Age 42 · axial length: 24.4 mm · intraocular pressure (IOP) 11 mmHg (non-contact tonometry) · man · autorefraction: sphere -3 D, cylinder -1.75 D, axis 110° · 30° FOV · corneal thickness 526 µm: 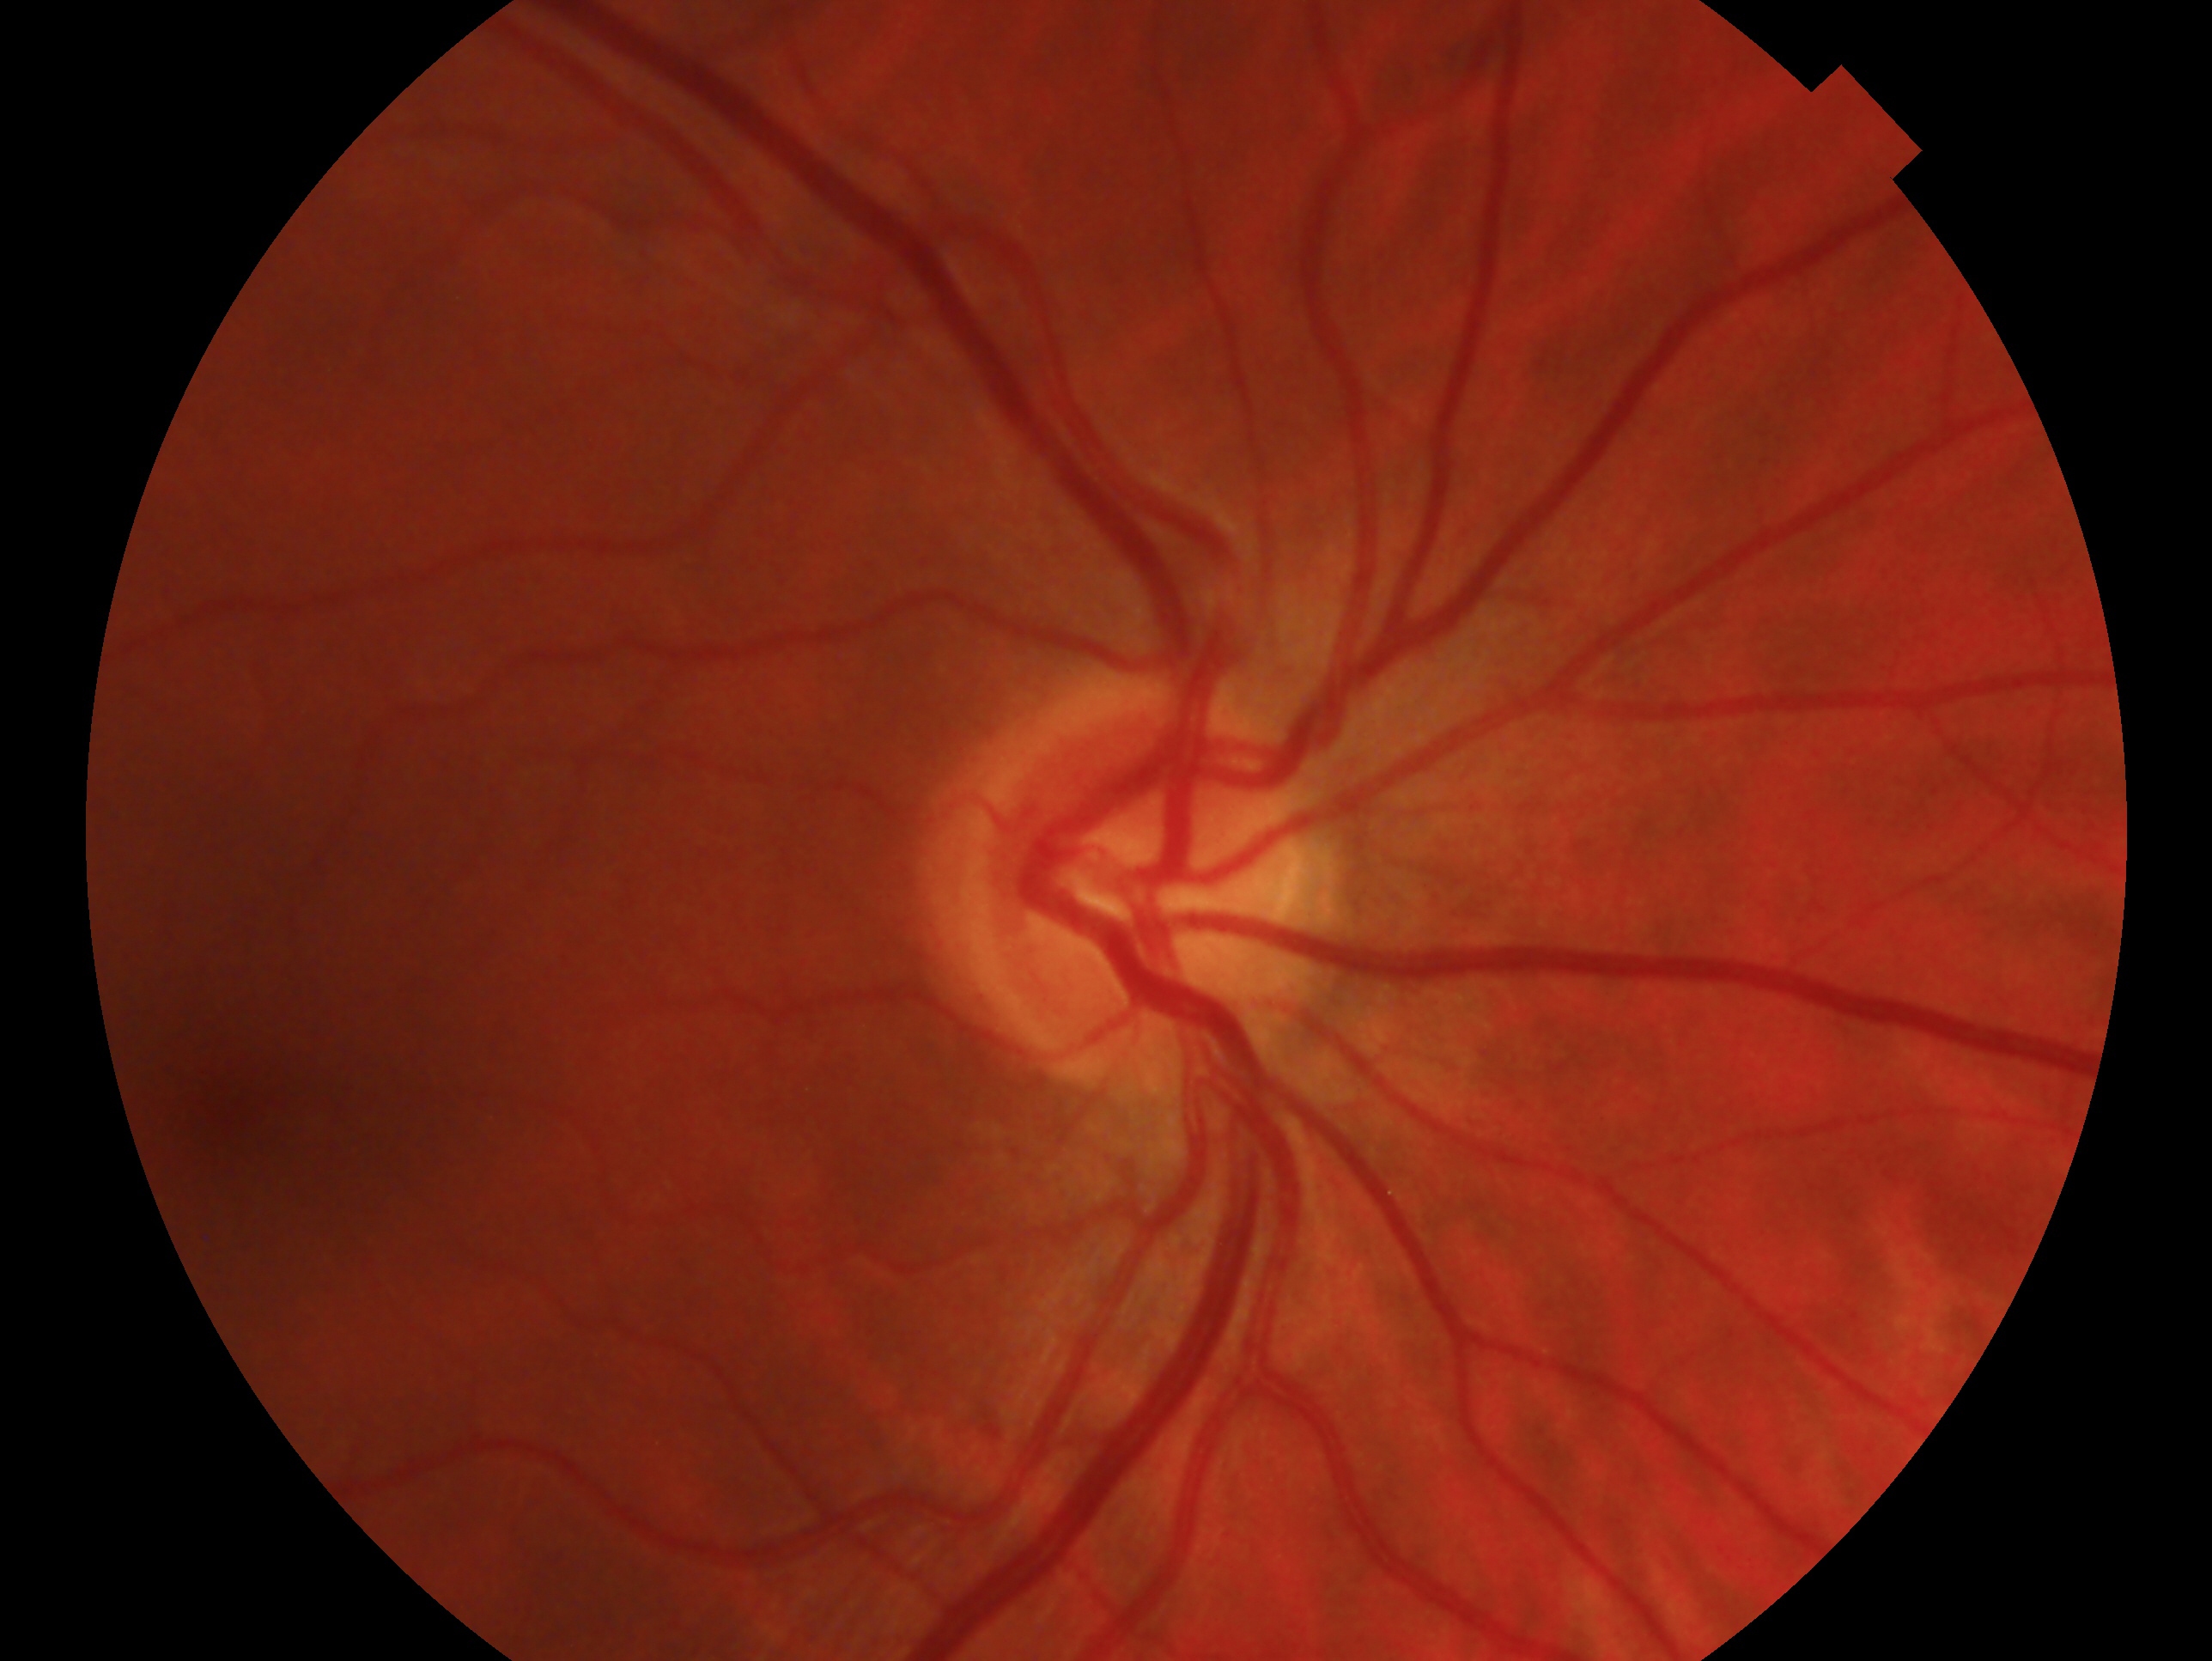 This is the right eye. Glaucoma diagnosis: negative for glaucoma.